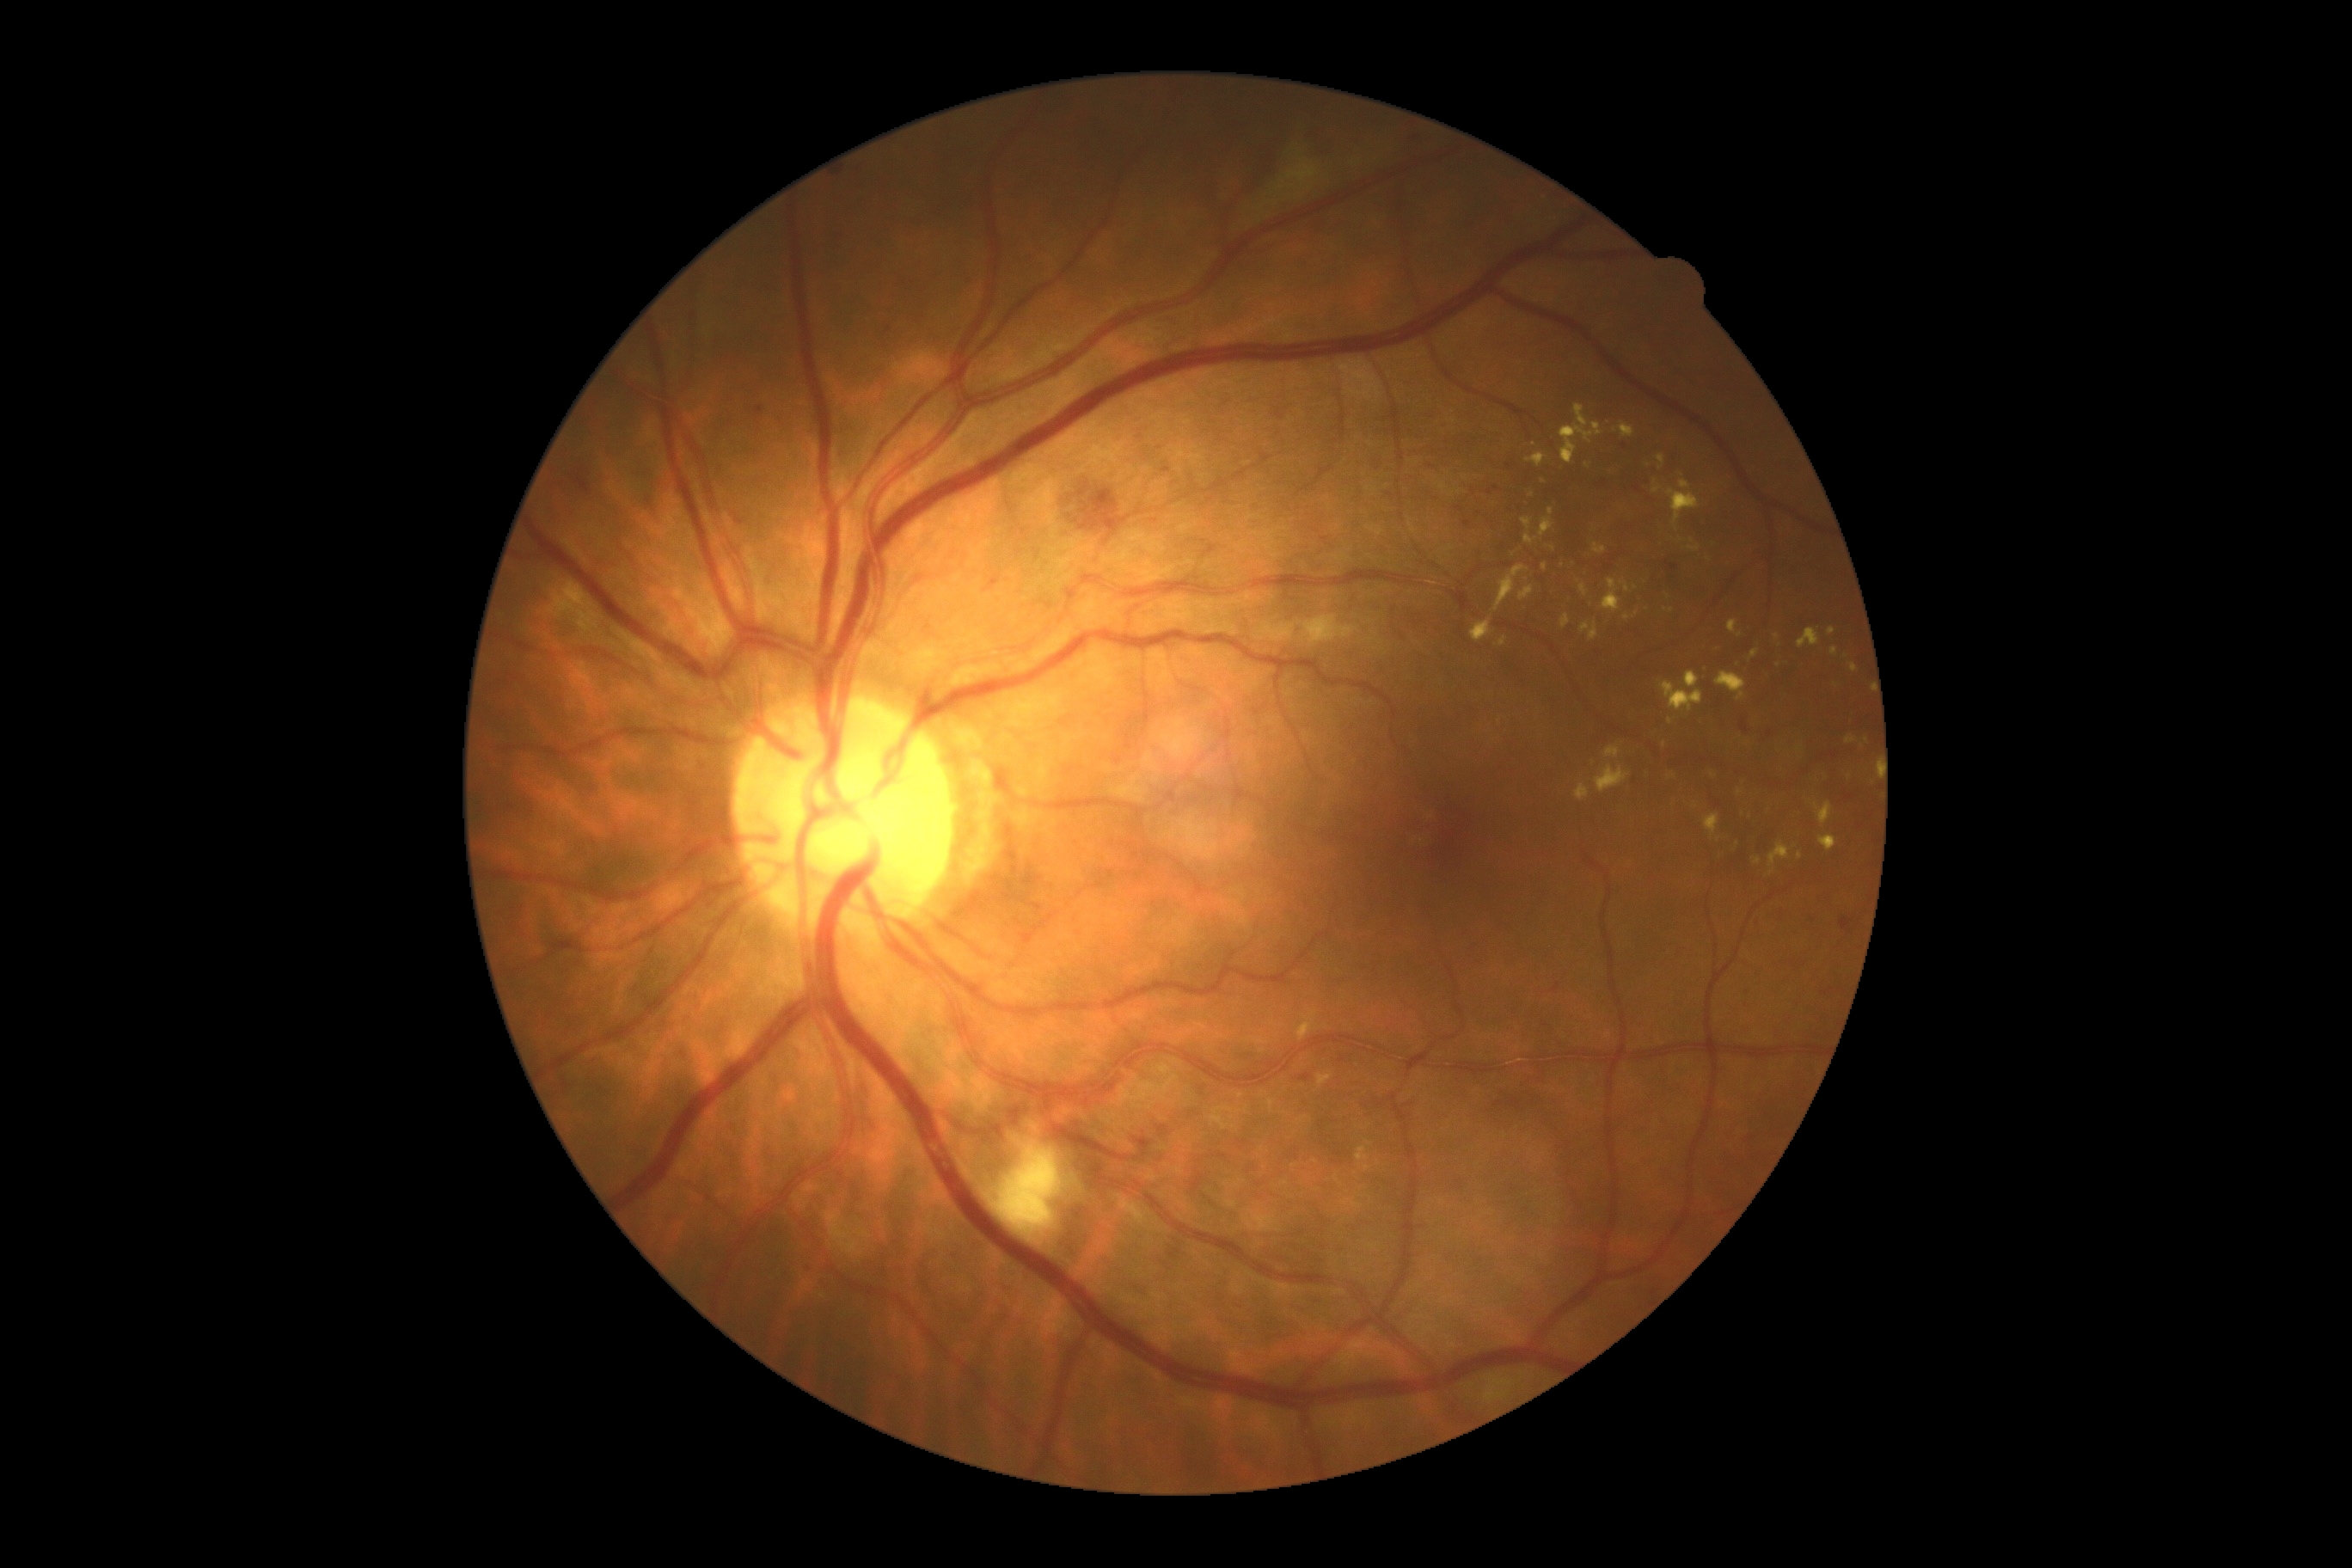

Retinopathy grade is 2 (moderate NPDR).